848 x 848 pixels.
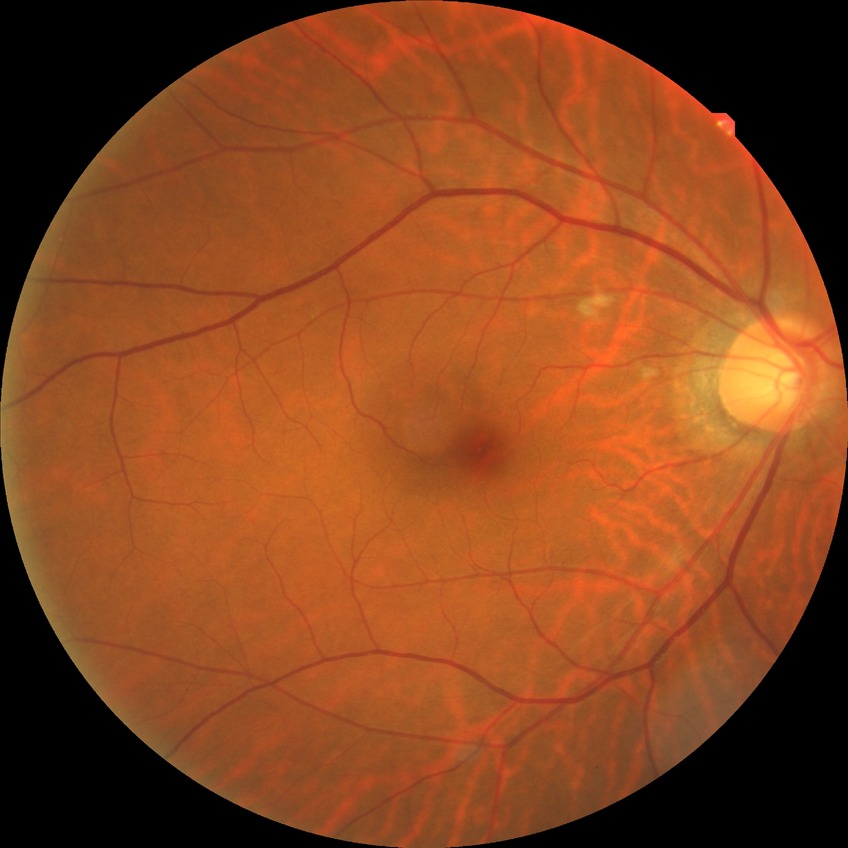
Davis grading: no diabetic retinopathy.